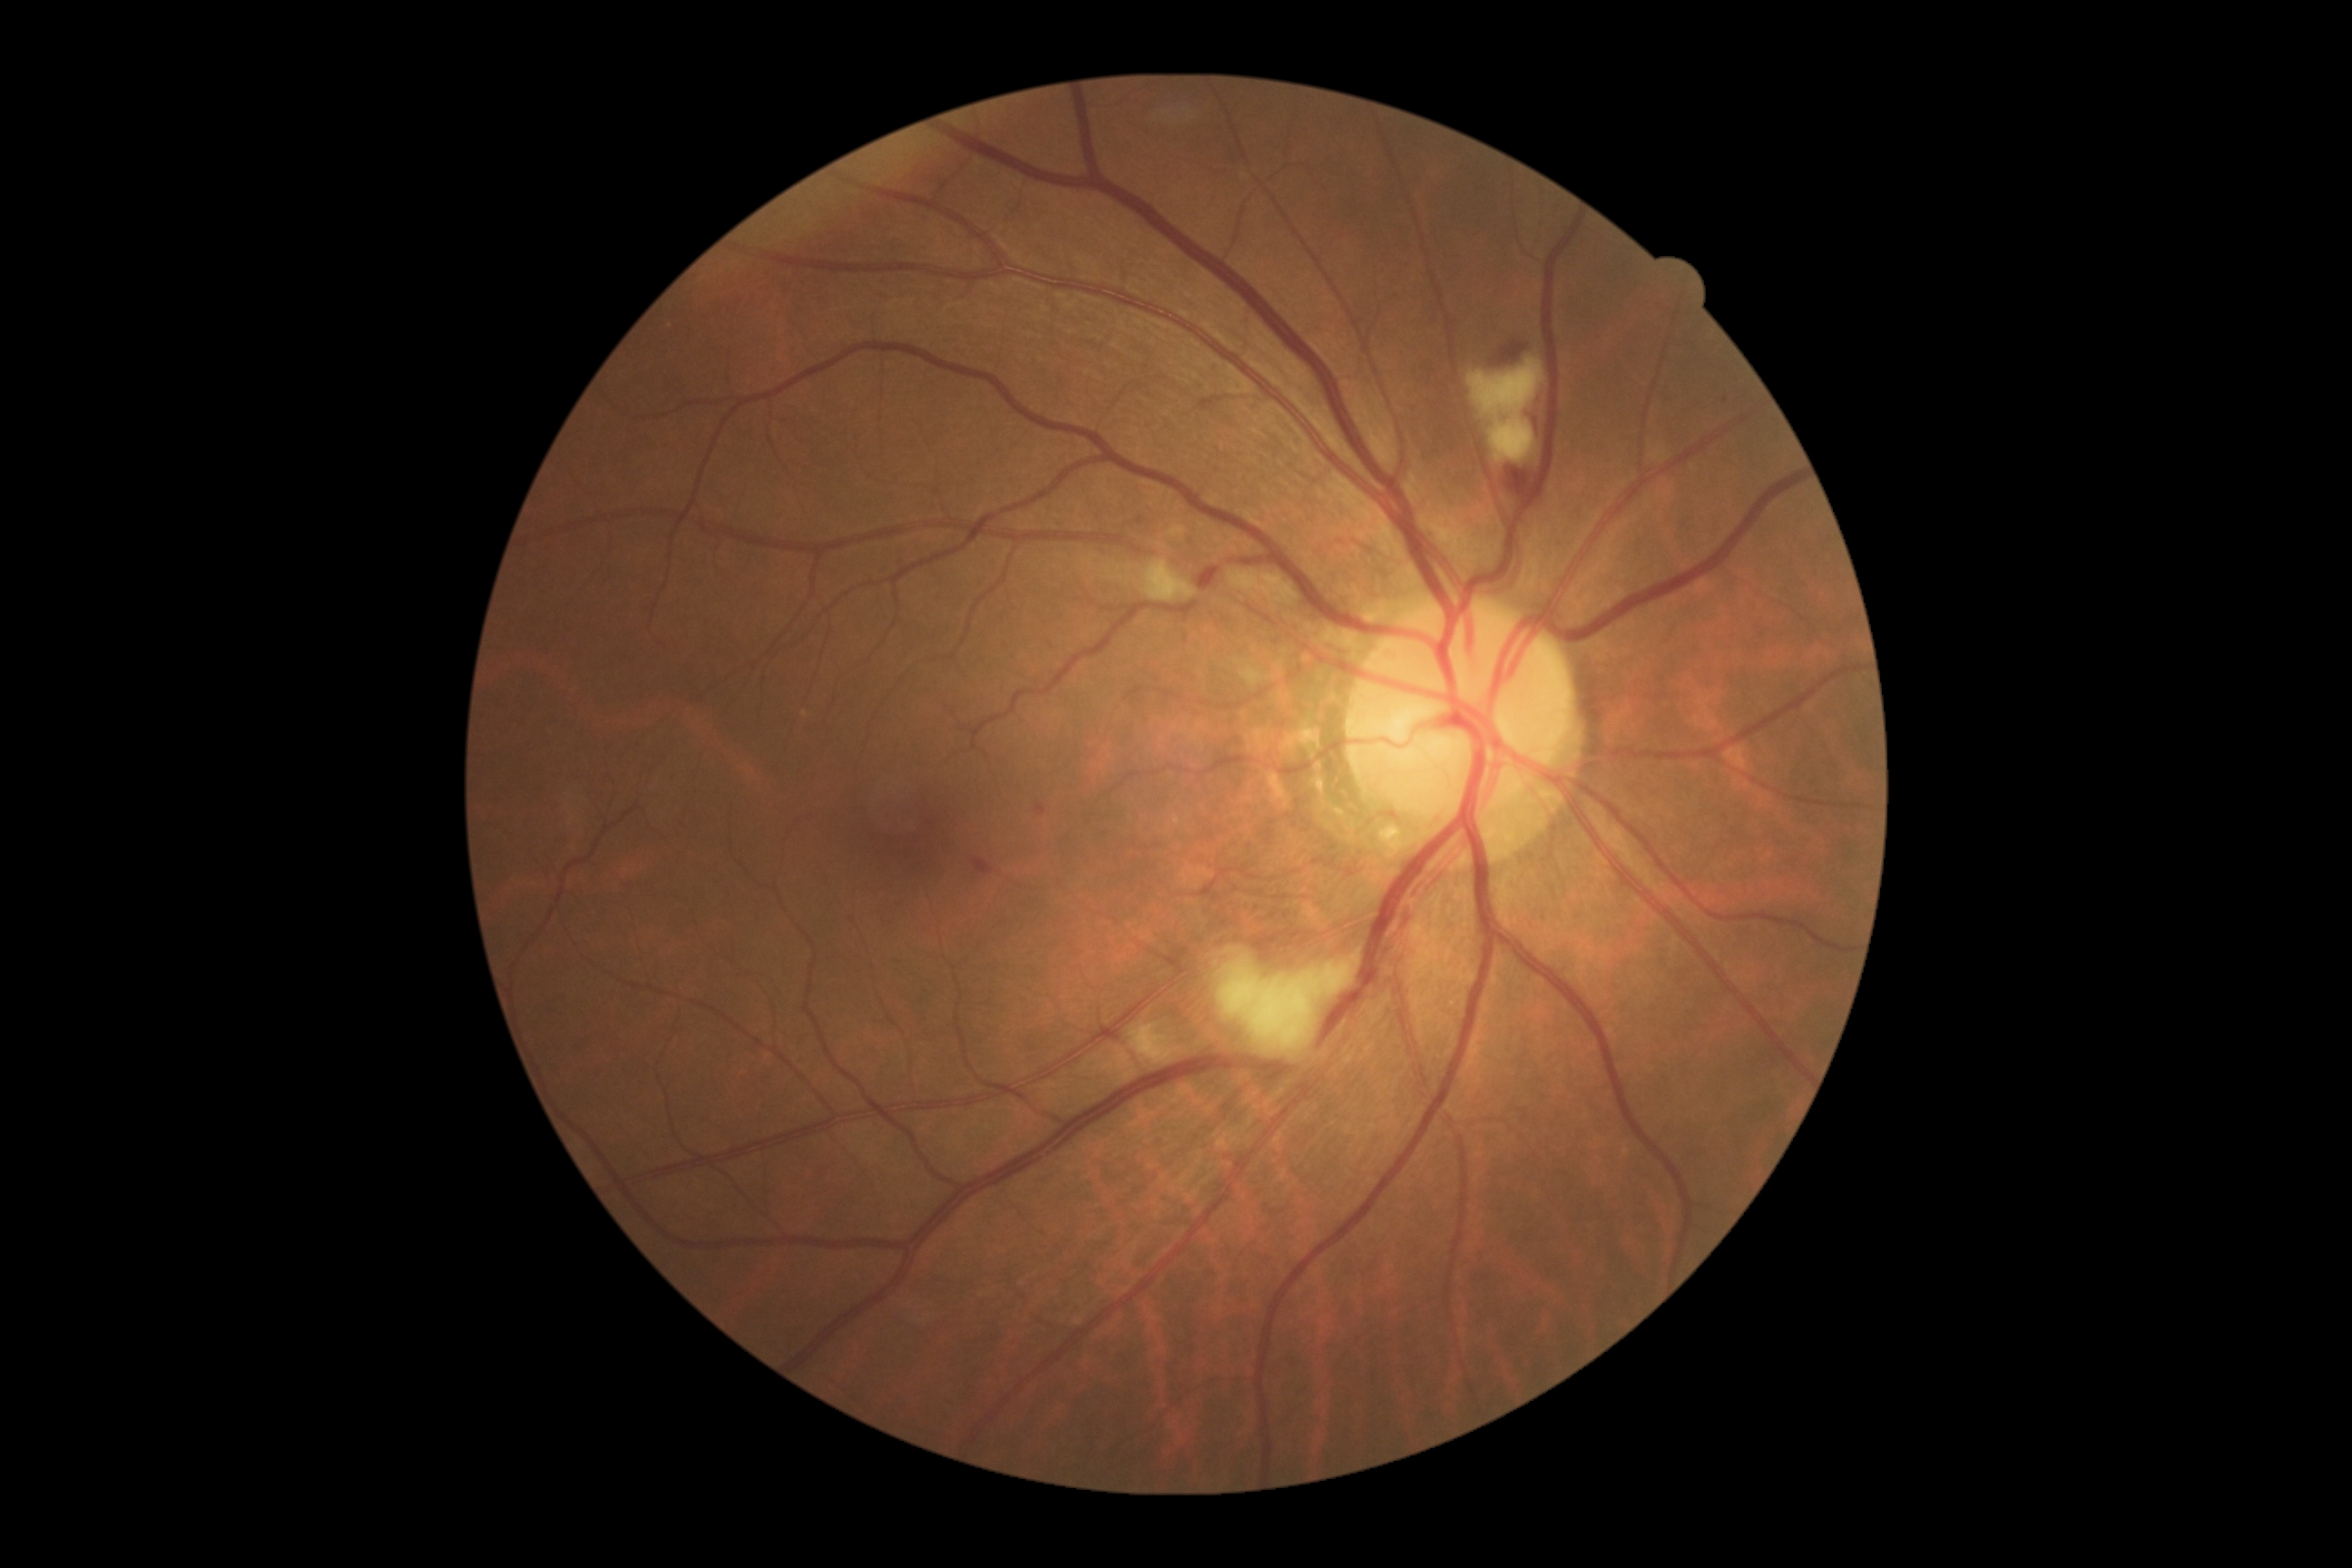 DR grade: 2.